No pharmacologic dilation · 45° FOV · fundus photo · NIDEK AFC-230 fundus camera — 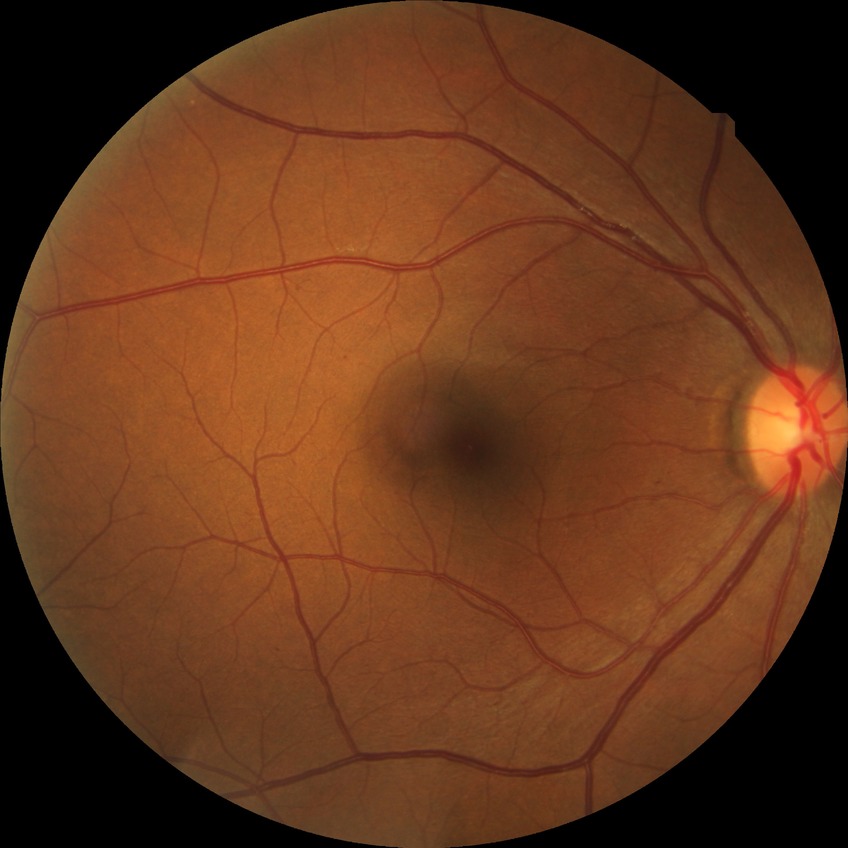
{"davis_grade": "simple diabetic retinopathy"}